Captured with the Phoenix ICON (100° field of view). Wide-field contact fundus photograph of an infant: 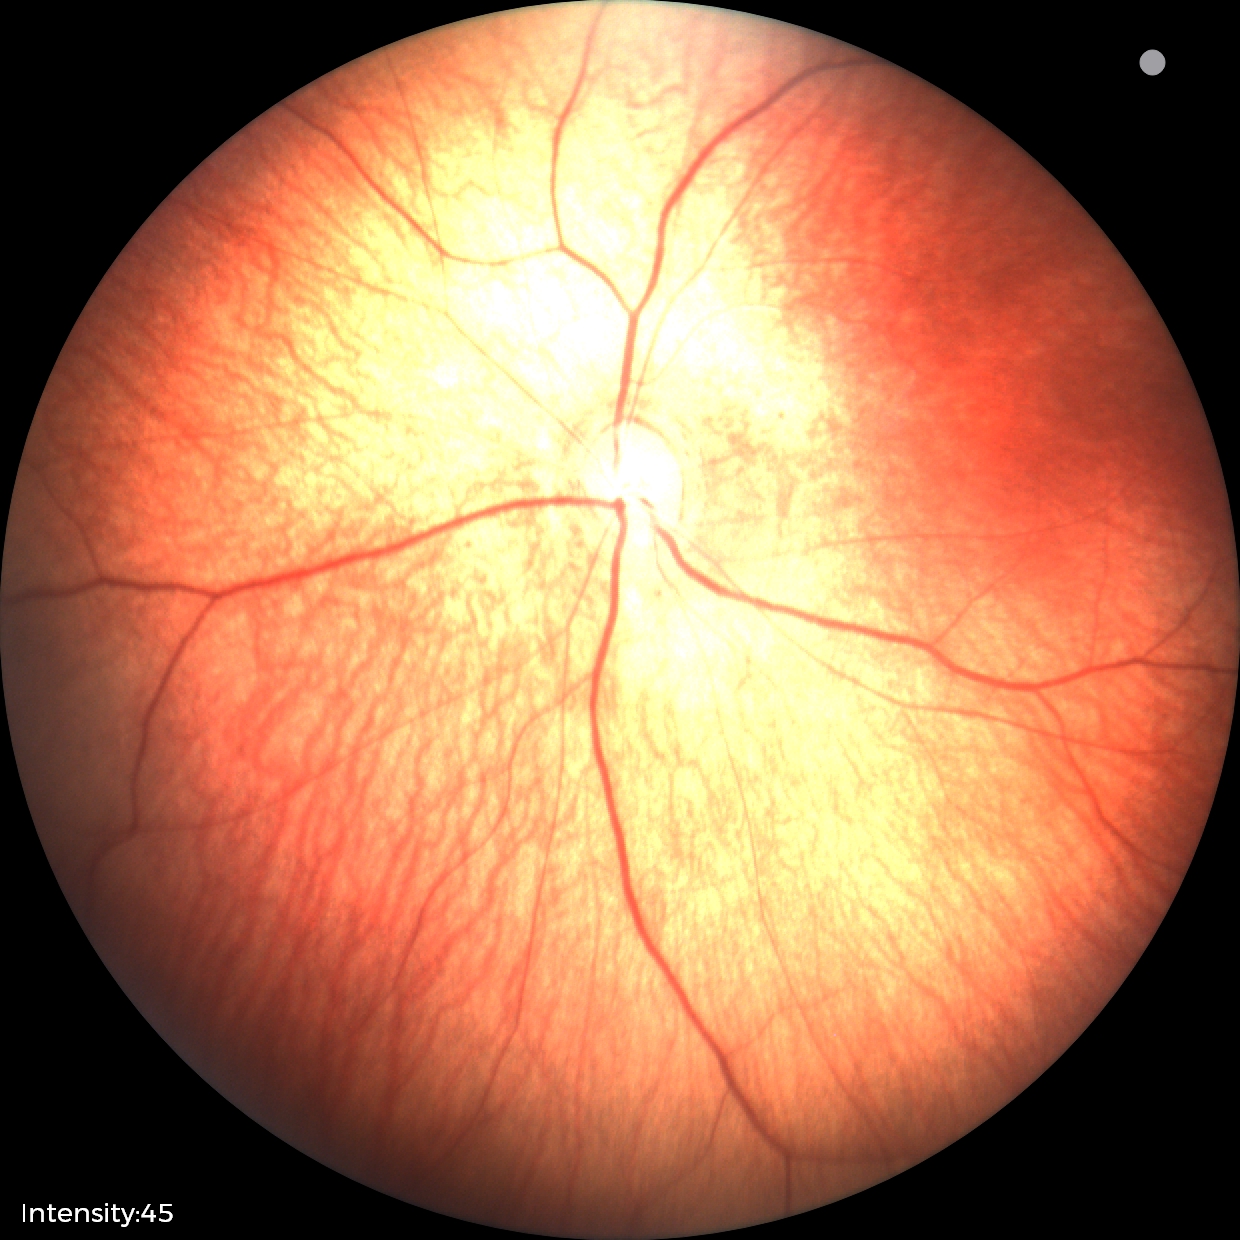

Examination with physiological retinal findings.